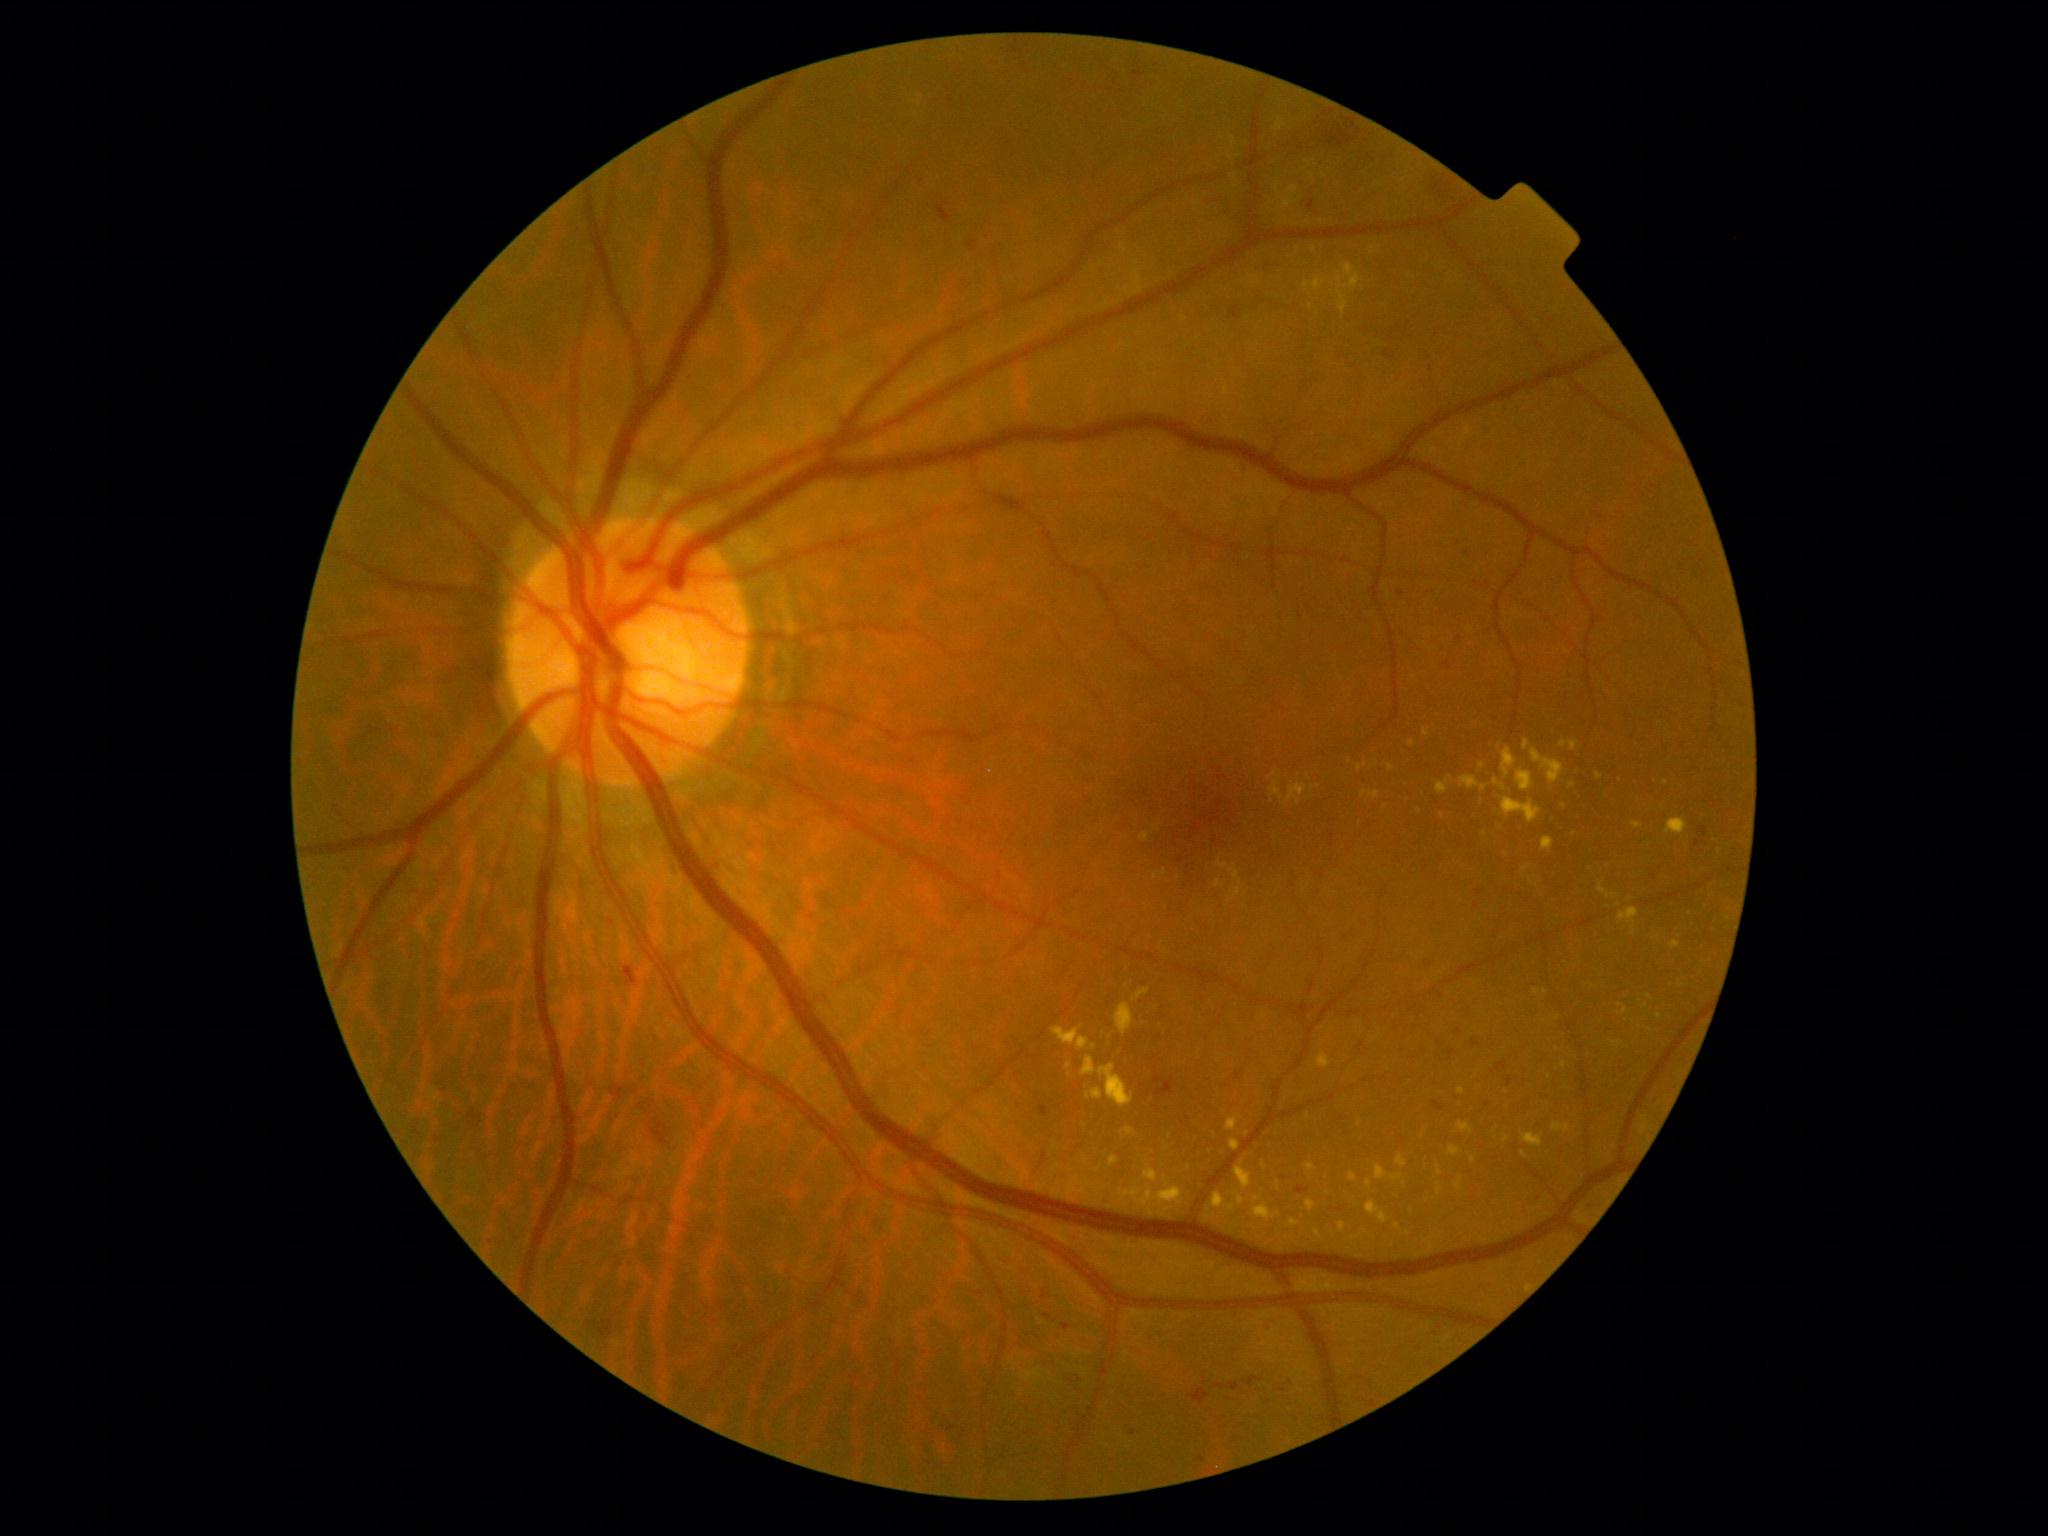 {"partial": true, "dr_grade": 2, "dr_grade_name": "moderate NPDR", "lesions": {"ma": [[1229, 1383, 1239, 1392], [942, 207, 949, 221], [1244, 465, 1249, 474], [1443, 661, 1452, 670], [1472, 1040, 1482, 1047], [1433, 1102, 1444, 1113], [1063, 1324, 1071, 1331], [1235, 1073, 1242, 1082], [1297, 1186, 1310, 1195]], "ma_small_approx": [[1459, 1032], [1698, 844], [1284, 1391], [1468, 554], [1401, 594], [1429, 963], [1654, 878]], "ex": [[1530, 749, 1565, 785], [1437, 1185, 1443, 1196], [1523, 740, 1530, 752], [1287, 1219, 1299, 1229], [1252, 1196, 1281, 1225], [1314, 1229, 1325, 1242], [1386, 765, 1394, 772], [1361, 791, 1380, 800], [1143, 1165, 1159, 1184], [1502, 747, 1518, 778], [1318, 1053, 1331, 1069], [1229, 865, 1242, 885], [1632, 822, 1644, 831]], "ex_small_approx": [[1667, 783], [1573, 785], [1482, 766], [1546, 992], [1069, 1066], [1557, 1019]]}}